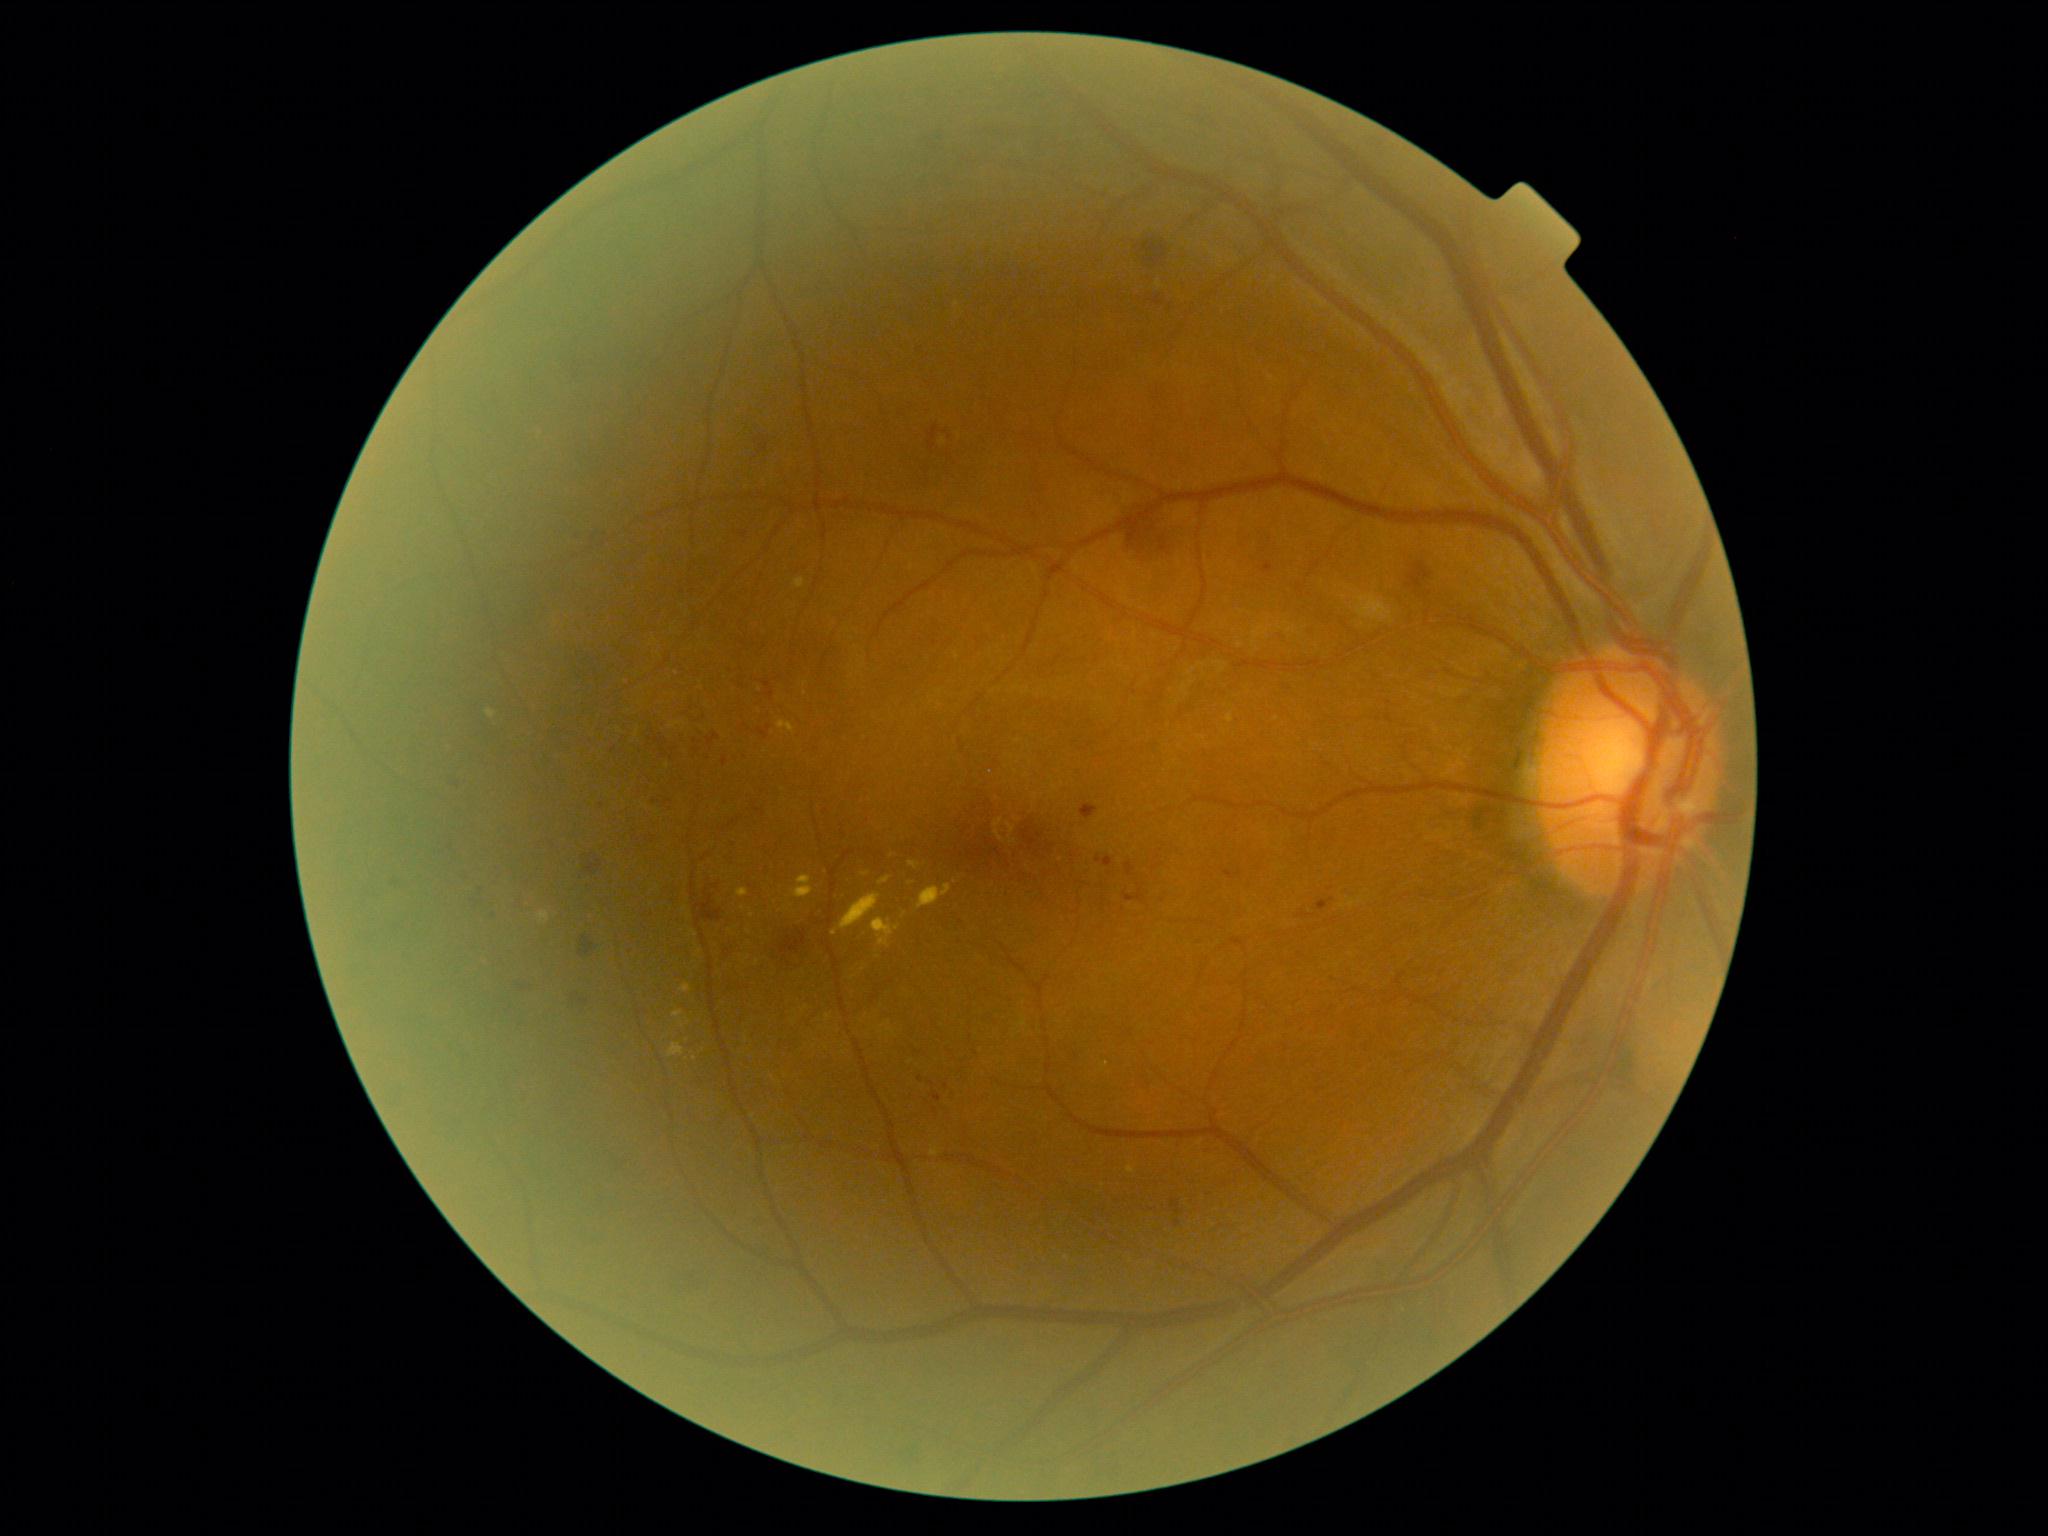
DR grade is moderate non-proliferative diabetic retinopathy (2).
MAs located at [1226,871,1236,878]; [1126,894,1135,901]; [933,1092,943,1102]; [1263,562,1273,574]; [1319,901,1330,908]; [1096,856,1114,868]; [1125,862,1135,877].
Smaller MAs around <pt>655,801</pt>; <pt>921,1079</pt>; <pt>946,1086</pt>; <pt>936,1111</pt>; <pt>603,806</pt>.
EXs include those at [795,578,805,588]; [1128,1165,1135,1174]; [872,918,901,948]; [673,1010,684,1017]; [668,1043,684,1058]; [839,892,881,930]; [681,984,693,993]; [538,911,550,924].
Smaller EXs around <pt>682,1024</pt>; <pt>695,1058</pt>; <pt>865,874</pt>.
HEs include those at [721,756,729,769]; [1171,1200,1183,1215]; [1081,805,1099,819]; [928,426,938,450]; [764,683,775,699]; [780,930,808,958]; [585,856,604,875]; [701,891,720,924]; [586,523,598,539]; [1126,515,1183,561]; [491,913,499,923]; [681,1271,707,1290]; [1139,238,1170,265].
Smaller HEs around <pt>470,897</pt>; <pt>745,535</pt>.
No SEs identified.